848x848 · posterior pole photograph: 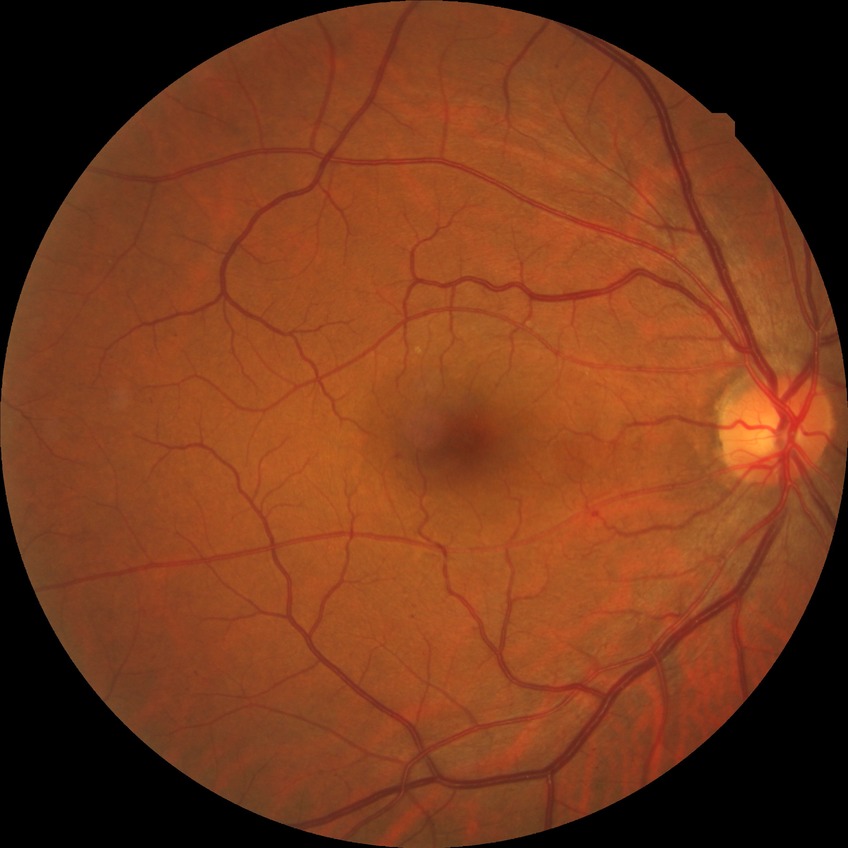

diabetic retinopathy (DR): simple diabetic retinopathy (SDR).